Pediatric wide-field fundus photograph
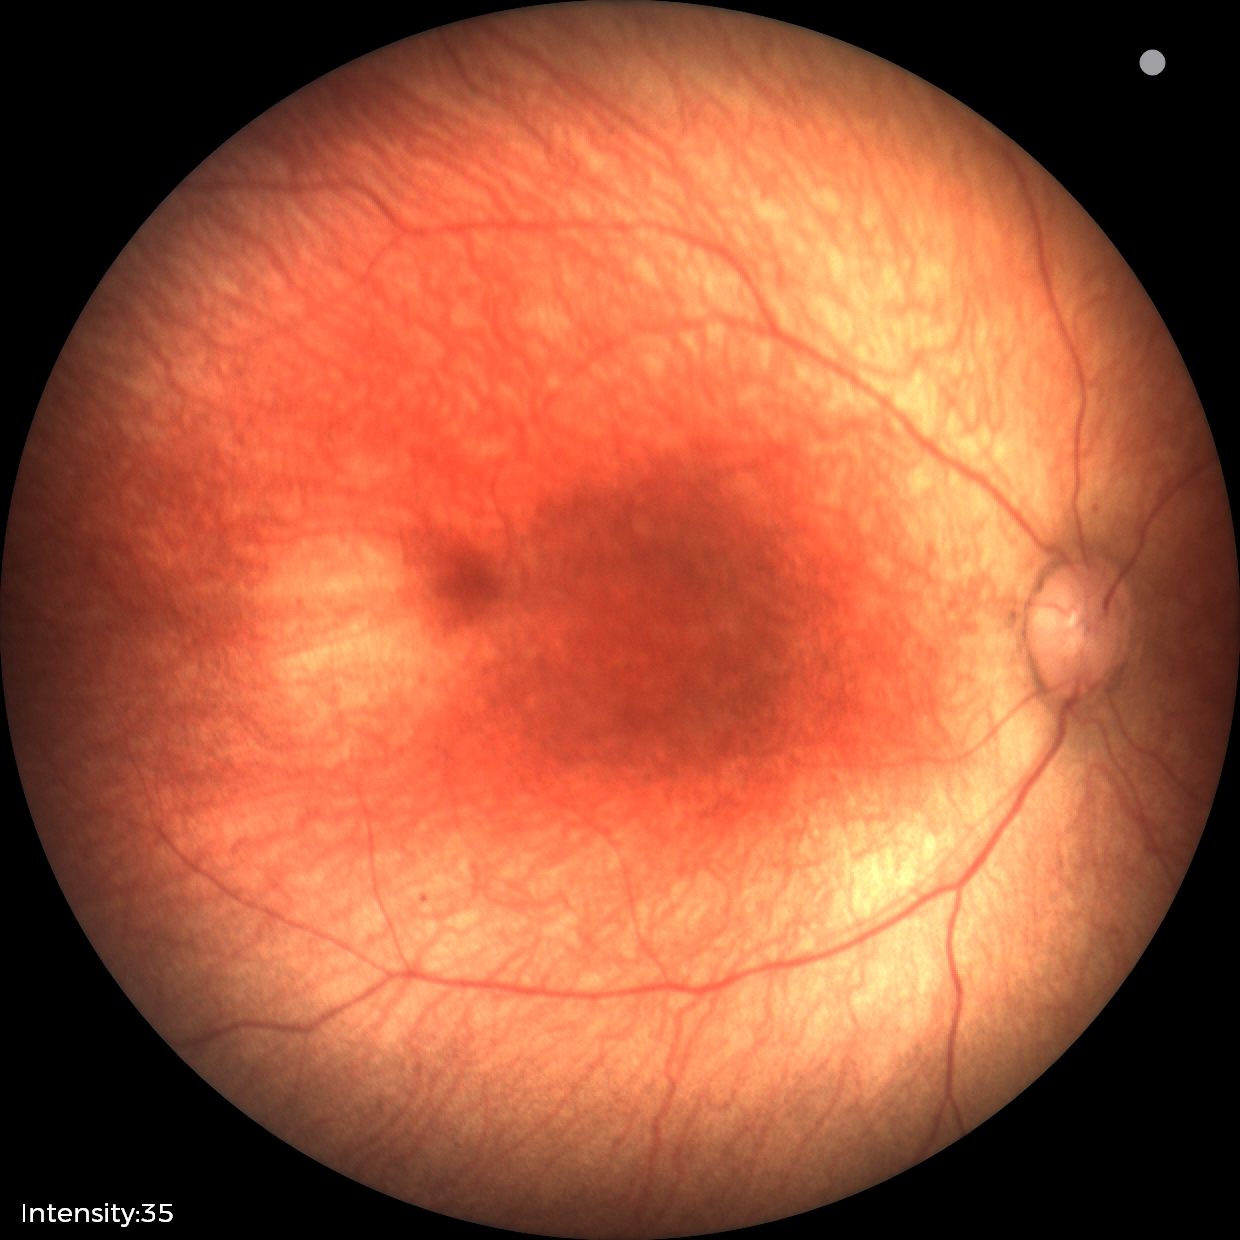

Screening examination with no abnormal retinal findings.